45-degree field of view · image size 2352x1568
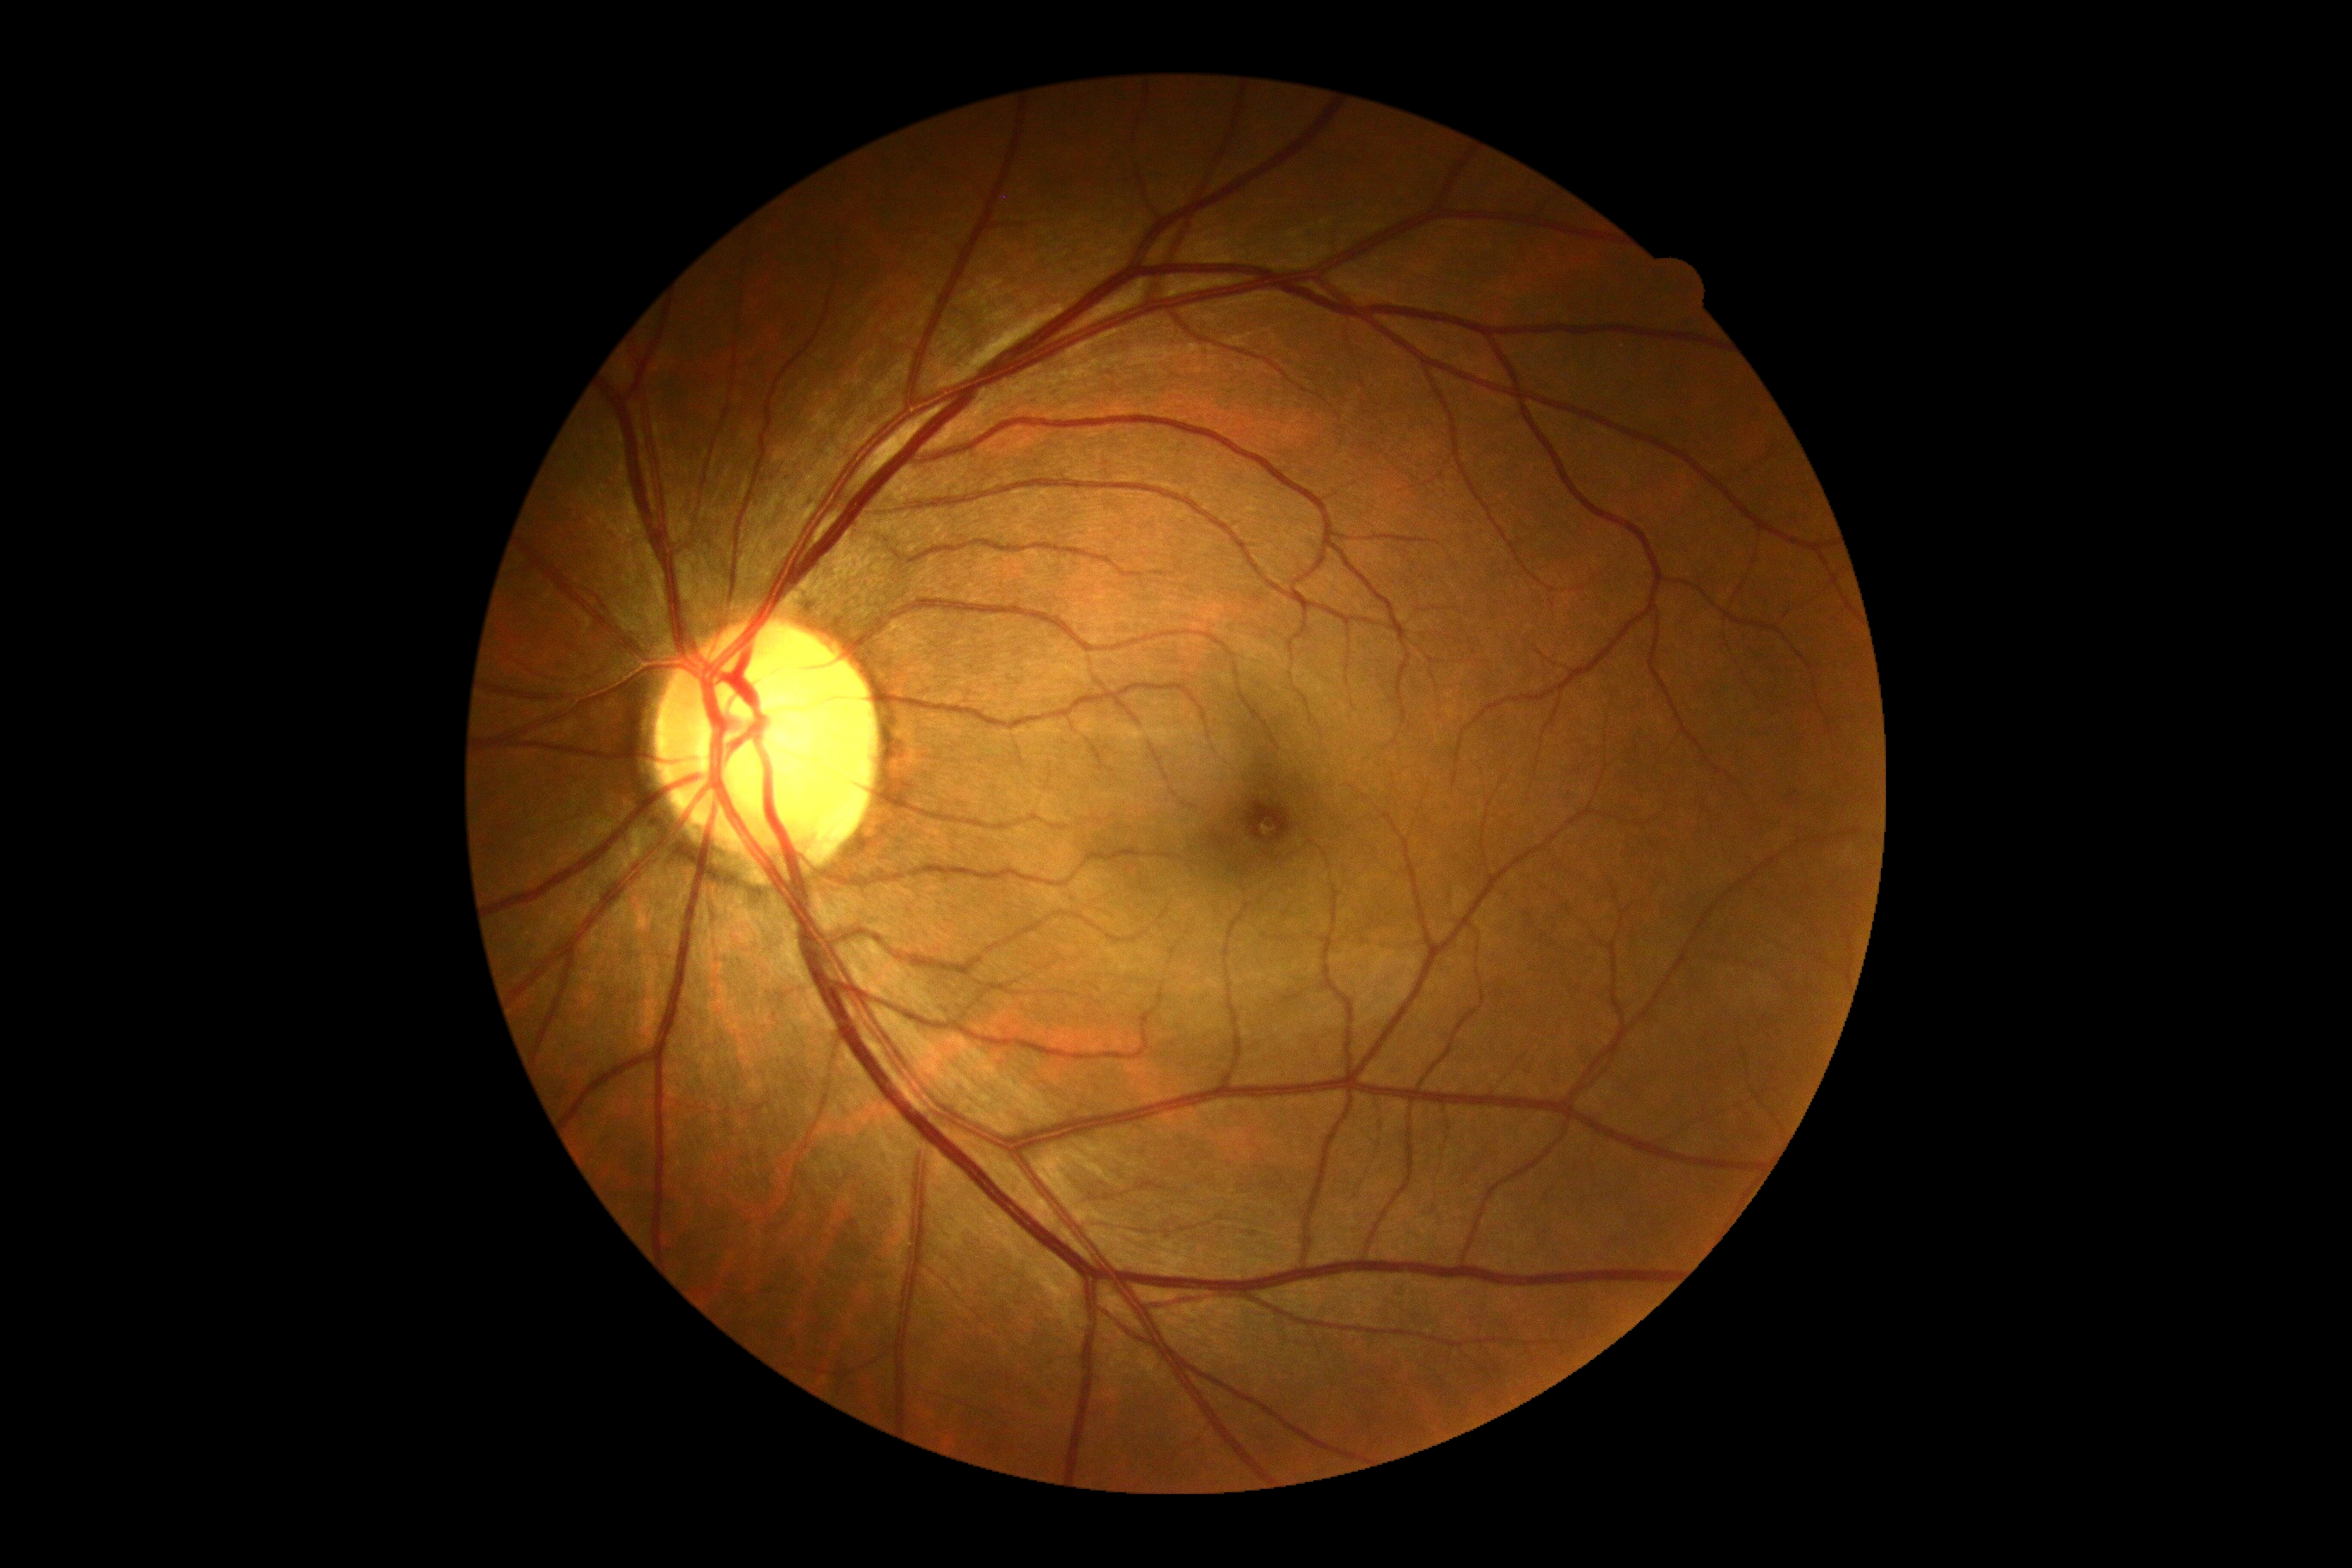
Diabetic retinopathy grade is no apparent retinopathy (0).